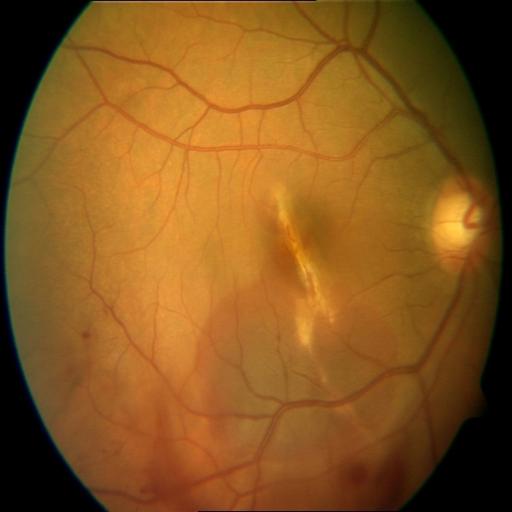
Impression: chorioretinitis (CRS) | hemorrhagic retinopathy (HR) | choroidal folds (CF).